Pediatric wide-field fundus photograph
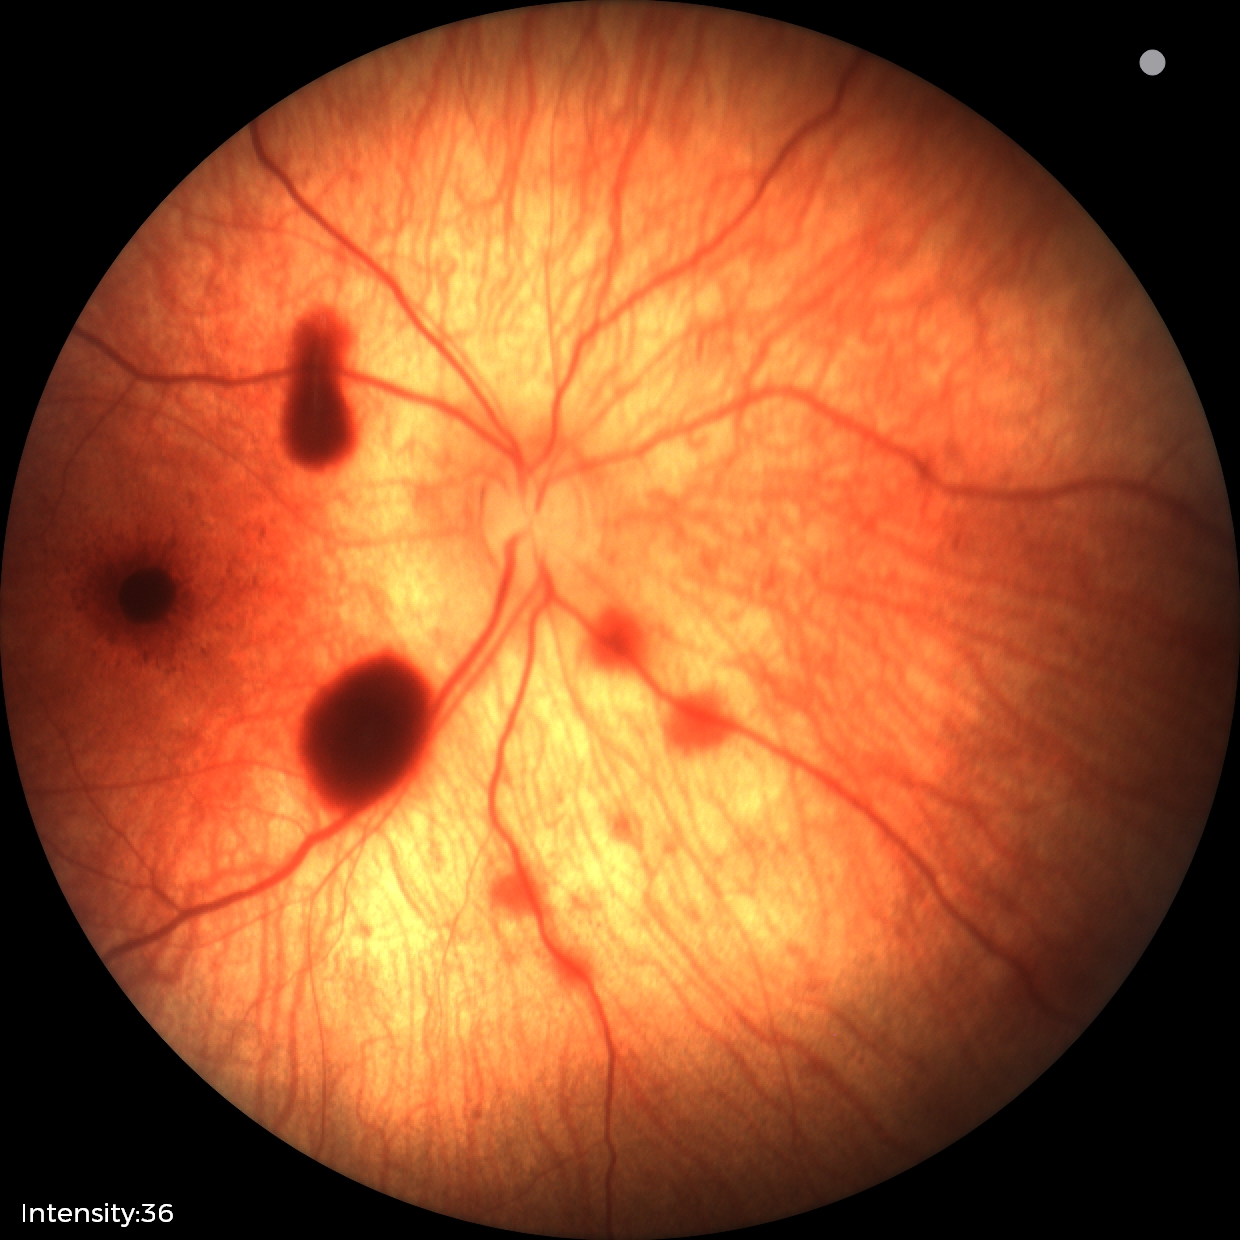
Screening diagnosis: retinal hemorrhages.